2352x1568, fundus photo — 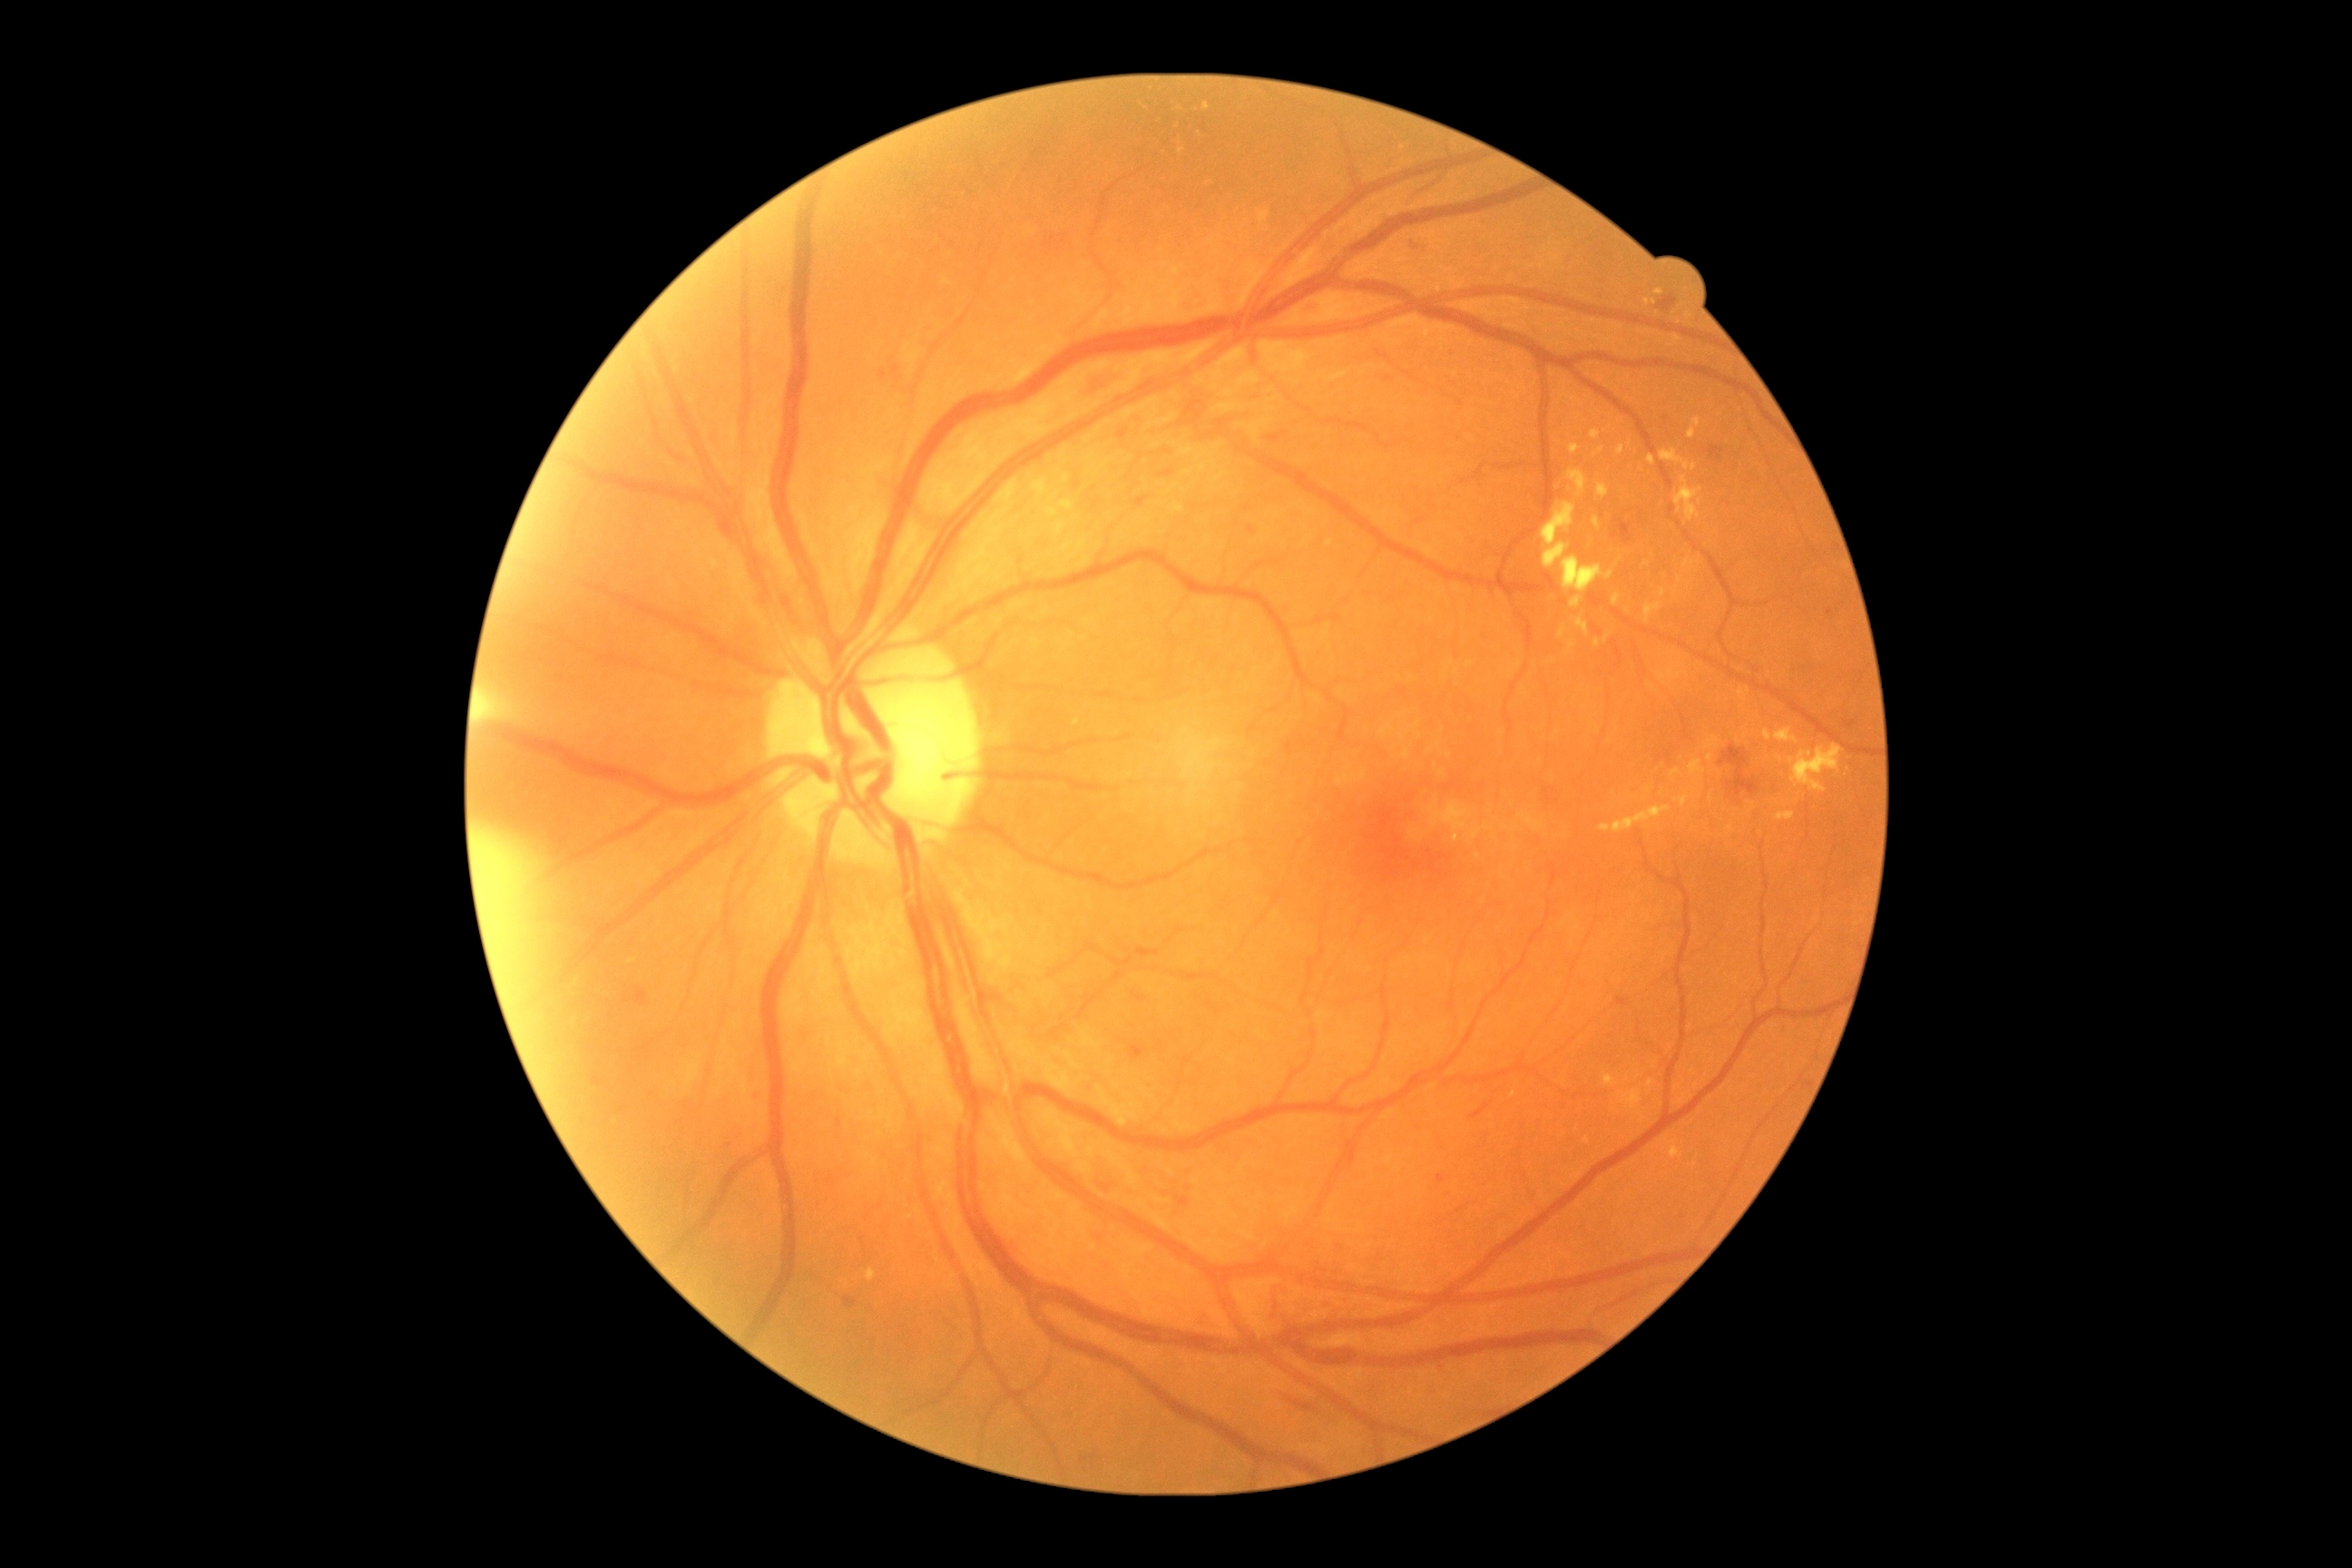 partial: true
dr_grade: 2
lesions:
  ex:
    - 1618,446,1625,455
    - 1571,444,1580,455
    - 1558,627,1565,640
    - 1689,760,1707,781
    - 1063,475,1070,484
    - 1591,429,1602,440
    - 1671,1142,1683,1159
    - 1032,478,1048,496
    - 1676,796,1690,807
    - 1674,476,1701,522
  ex_small_approx:
    - x=1621 y=558
    - x=1646 y=564
    - x=1710 y=797
    - x=1182 y=150
    - x=1650 y=1084